Infant wide-field retinal image.
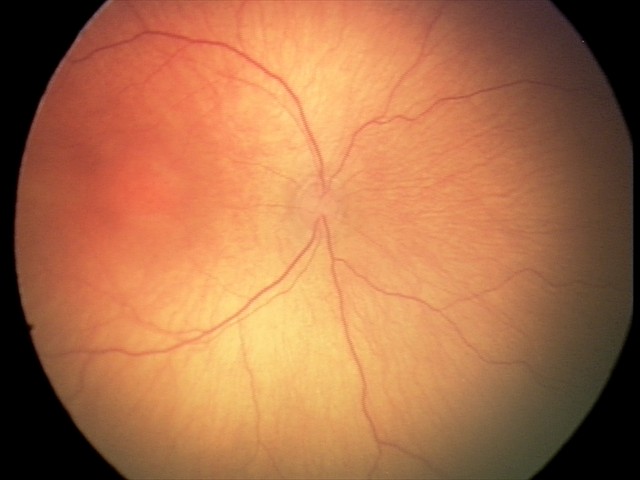 Plus form: absent | retinopathy of prematurity (ROP): stage 2 — ridge with height and width at the demarcation line.